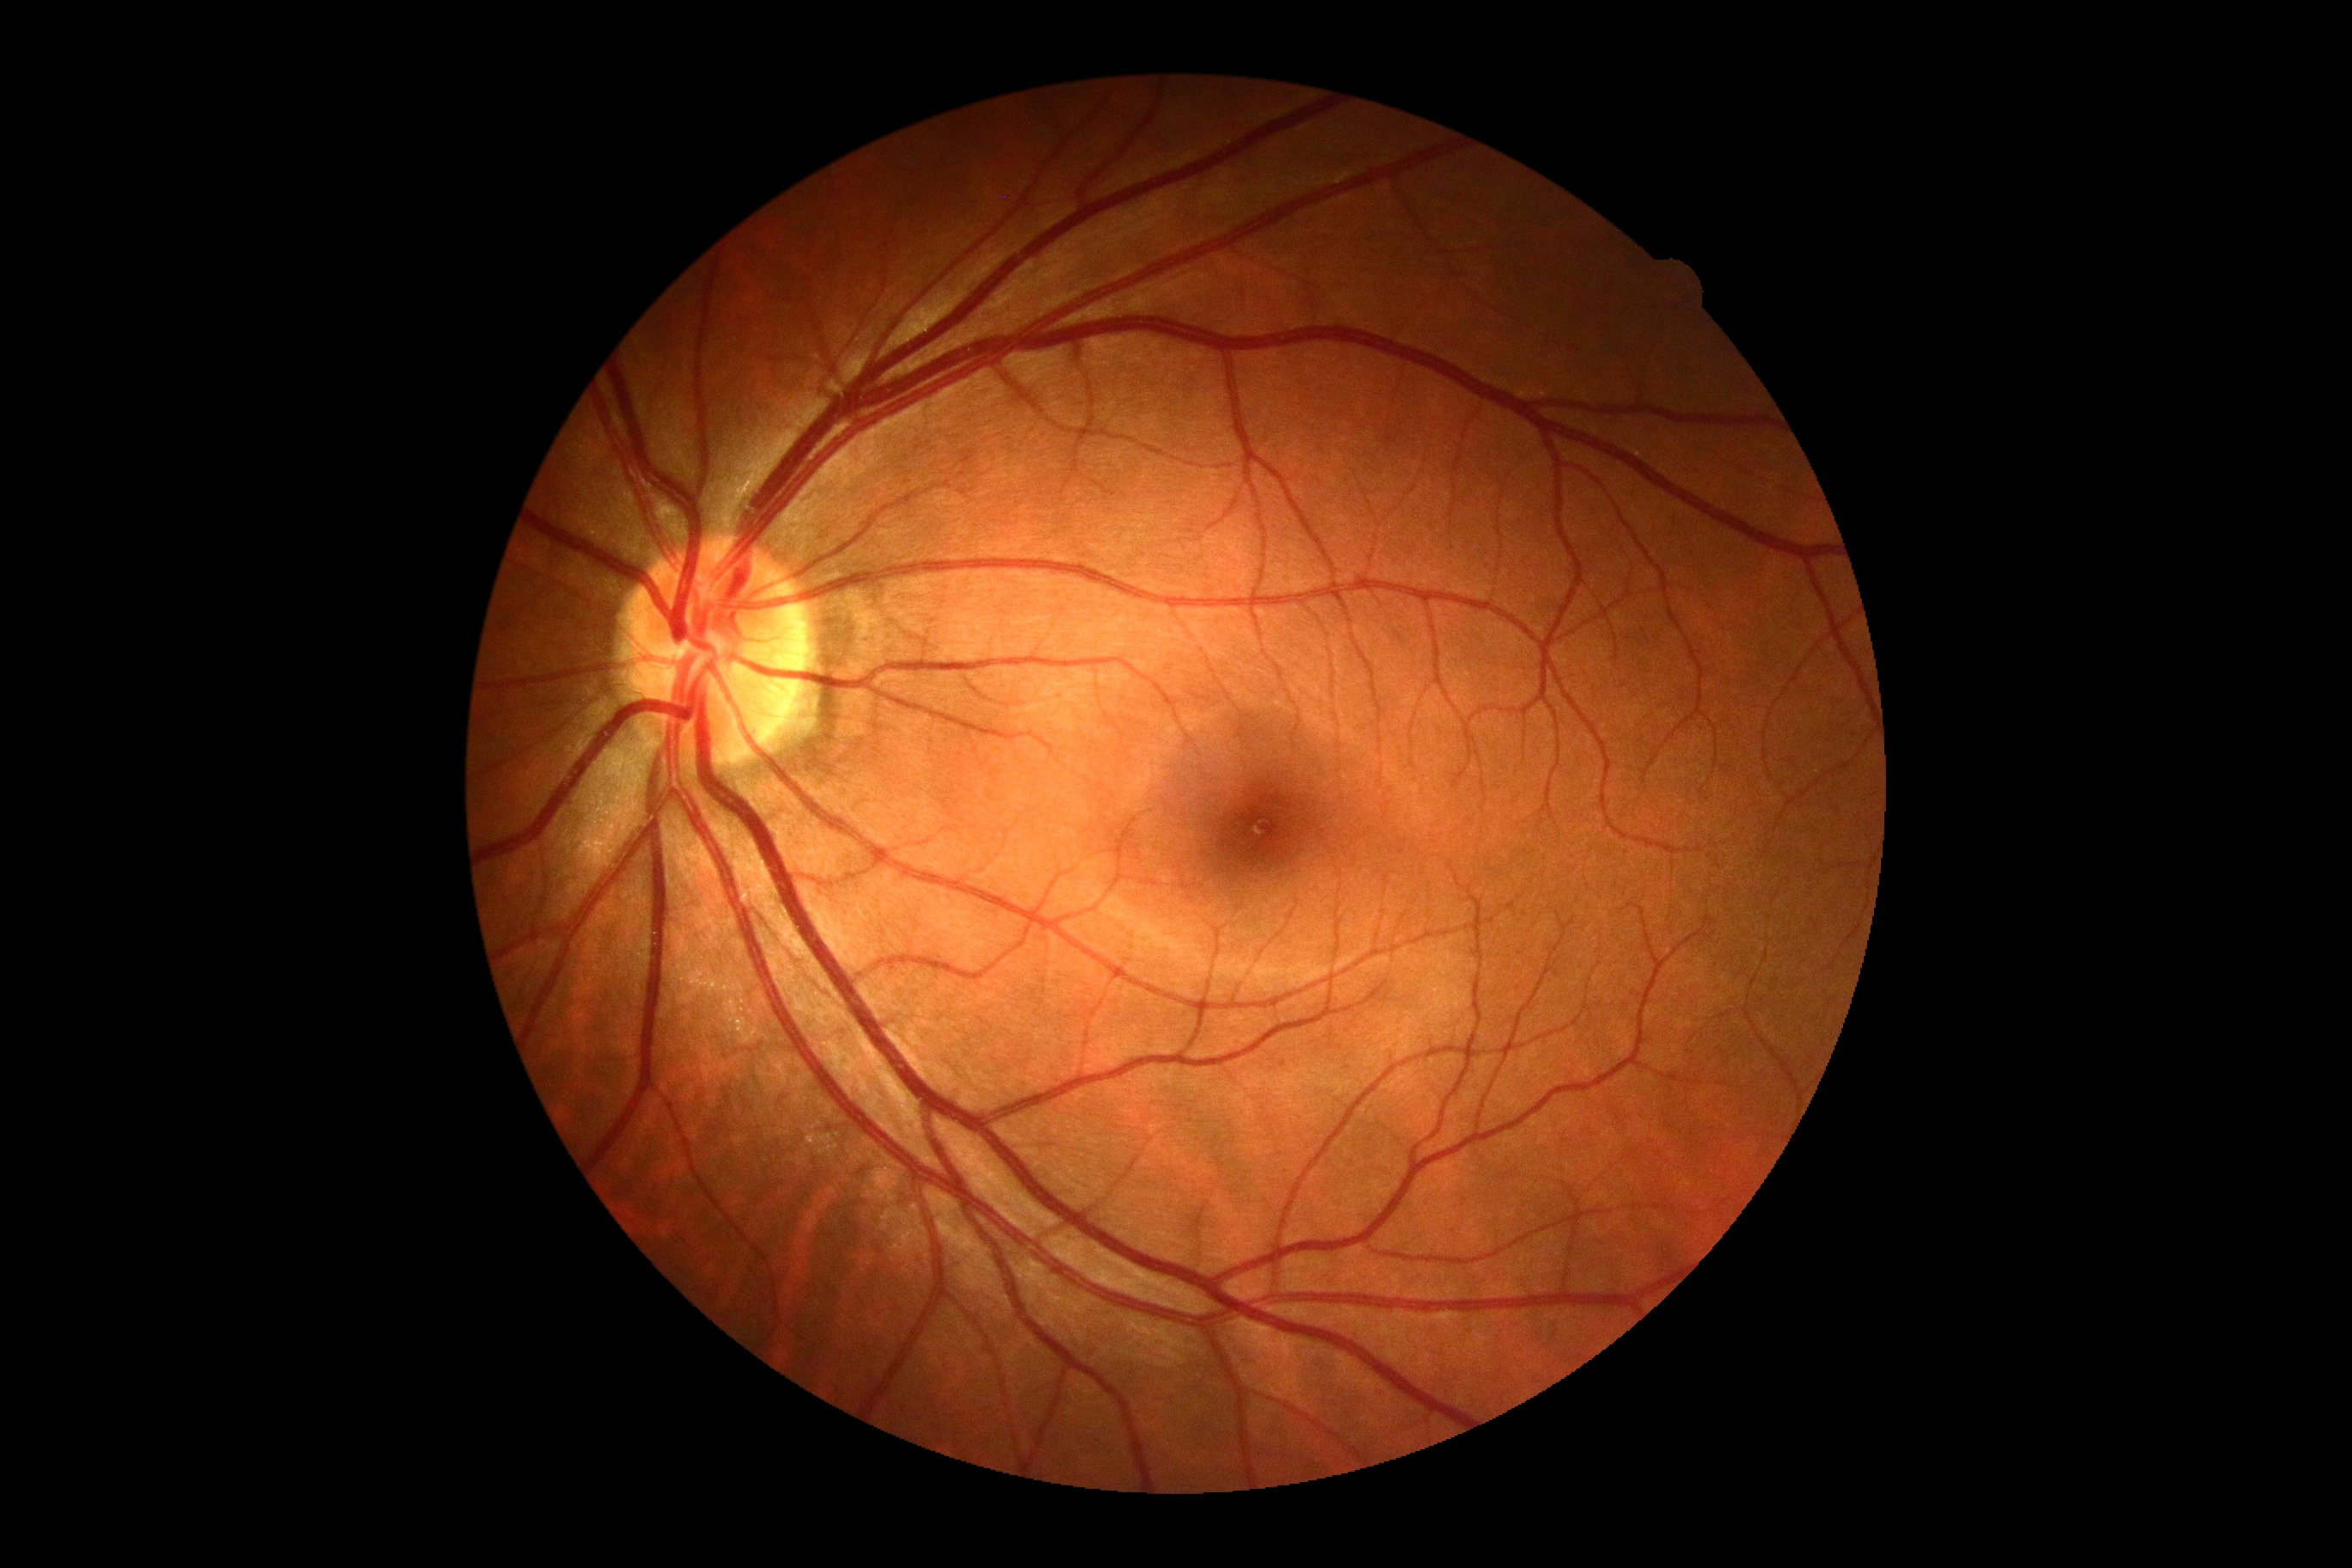
Findings:
- DR grade: no apparent diabetic retinopathy (0)